848x848px. Nonmydriatic. Camera: NIDEK AFC-230:
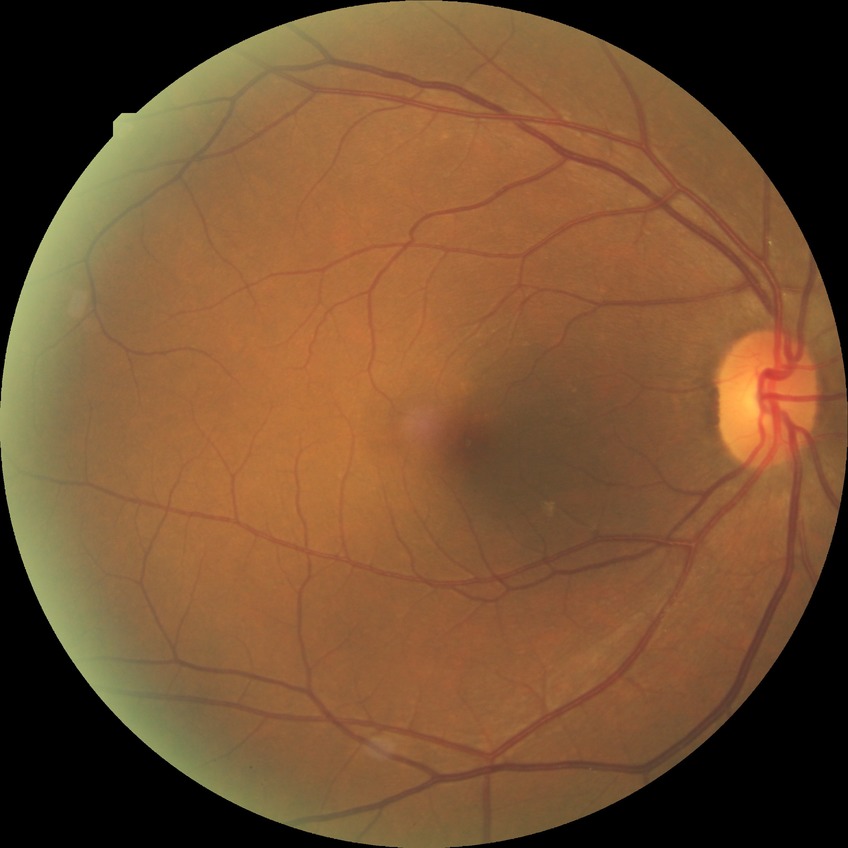 Diabetic retinopathy (DR) is NDR (no diabetic retinopathy).